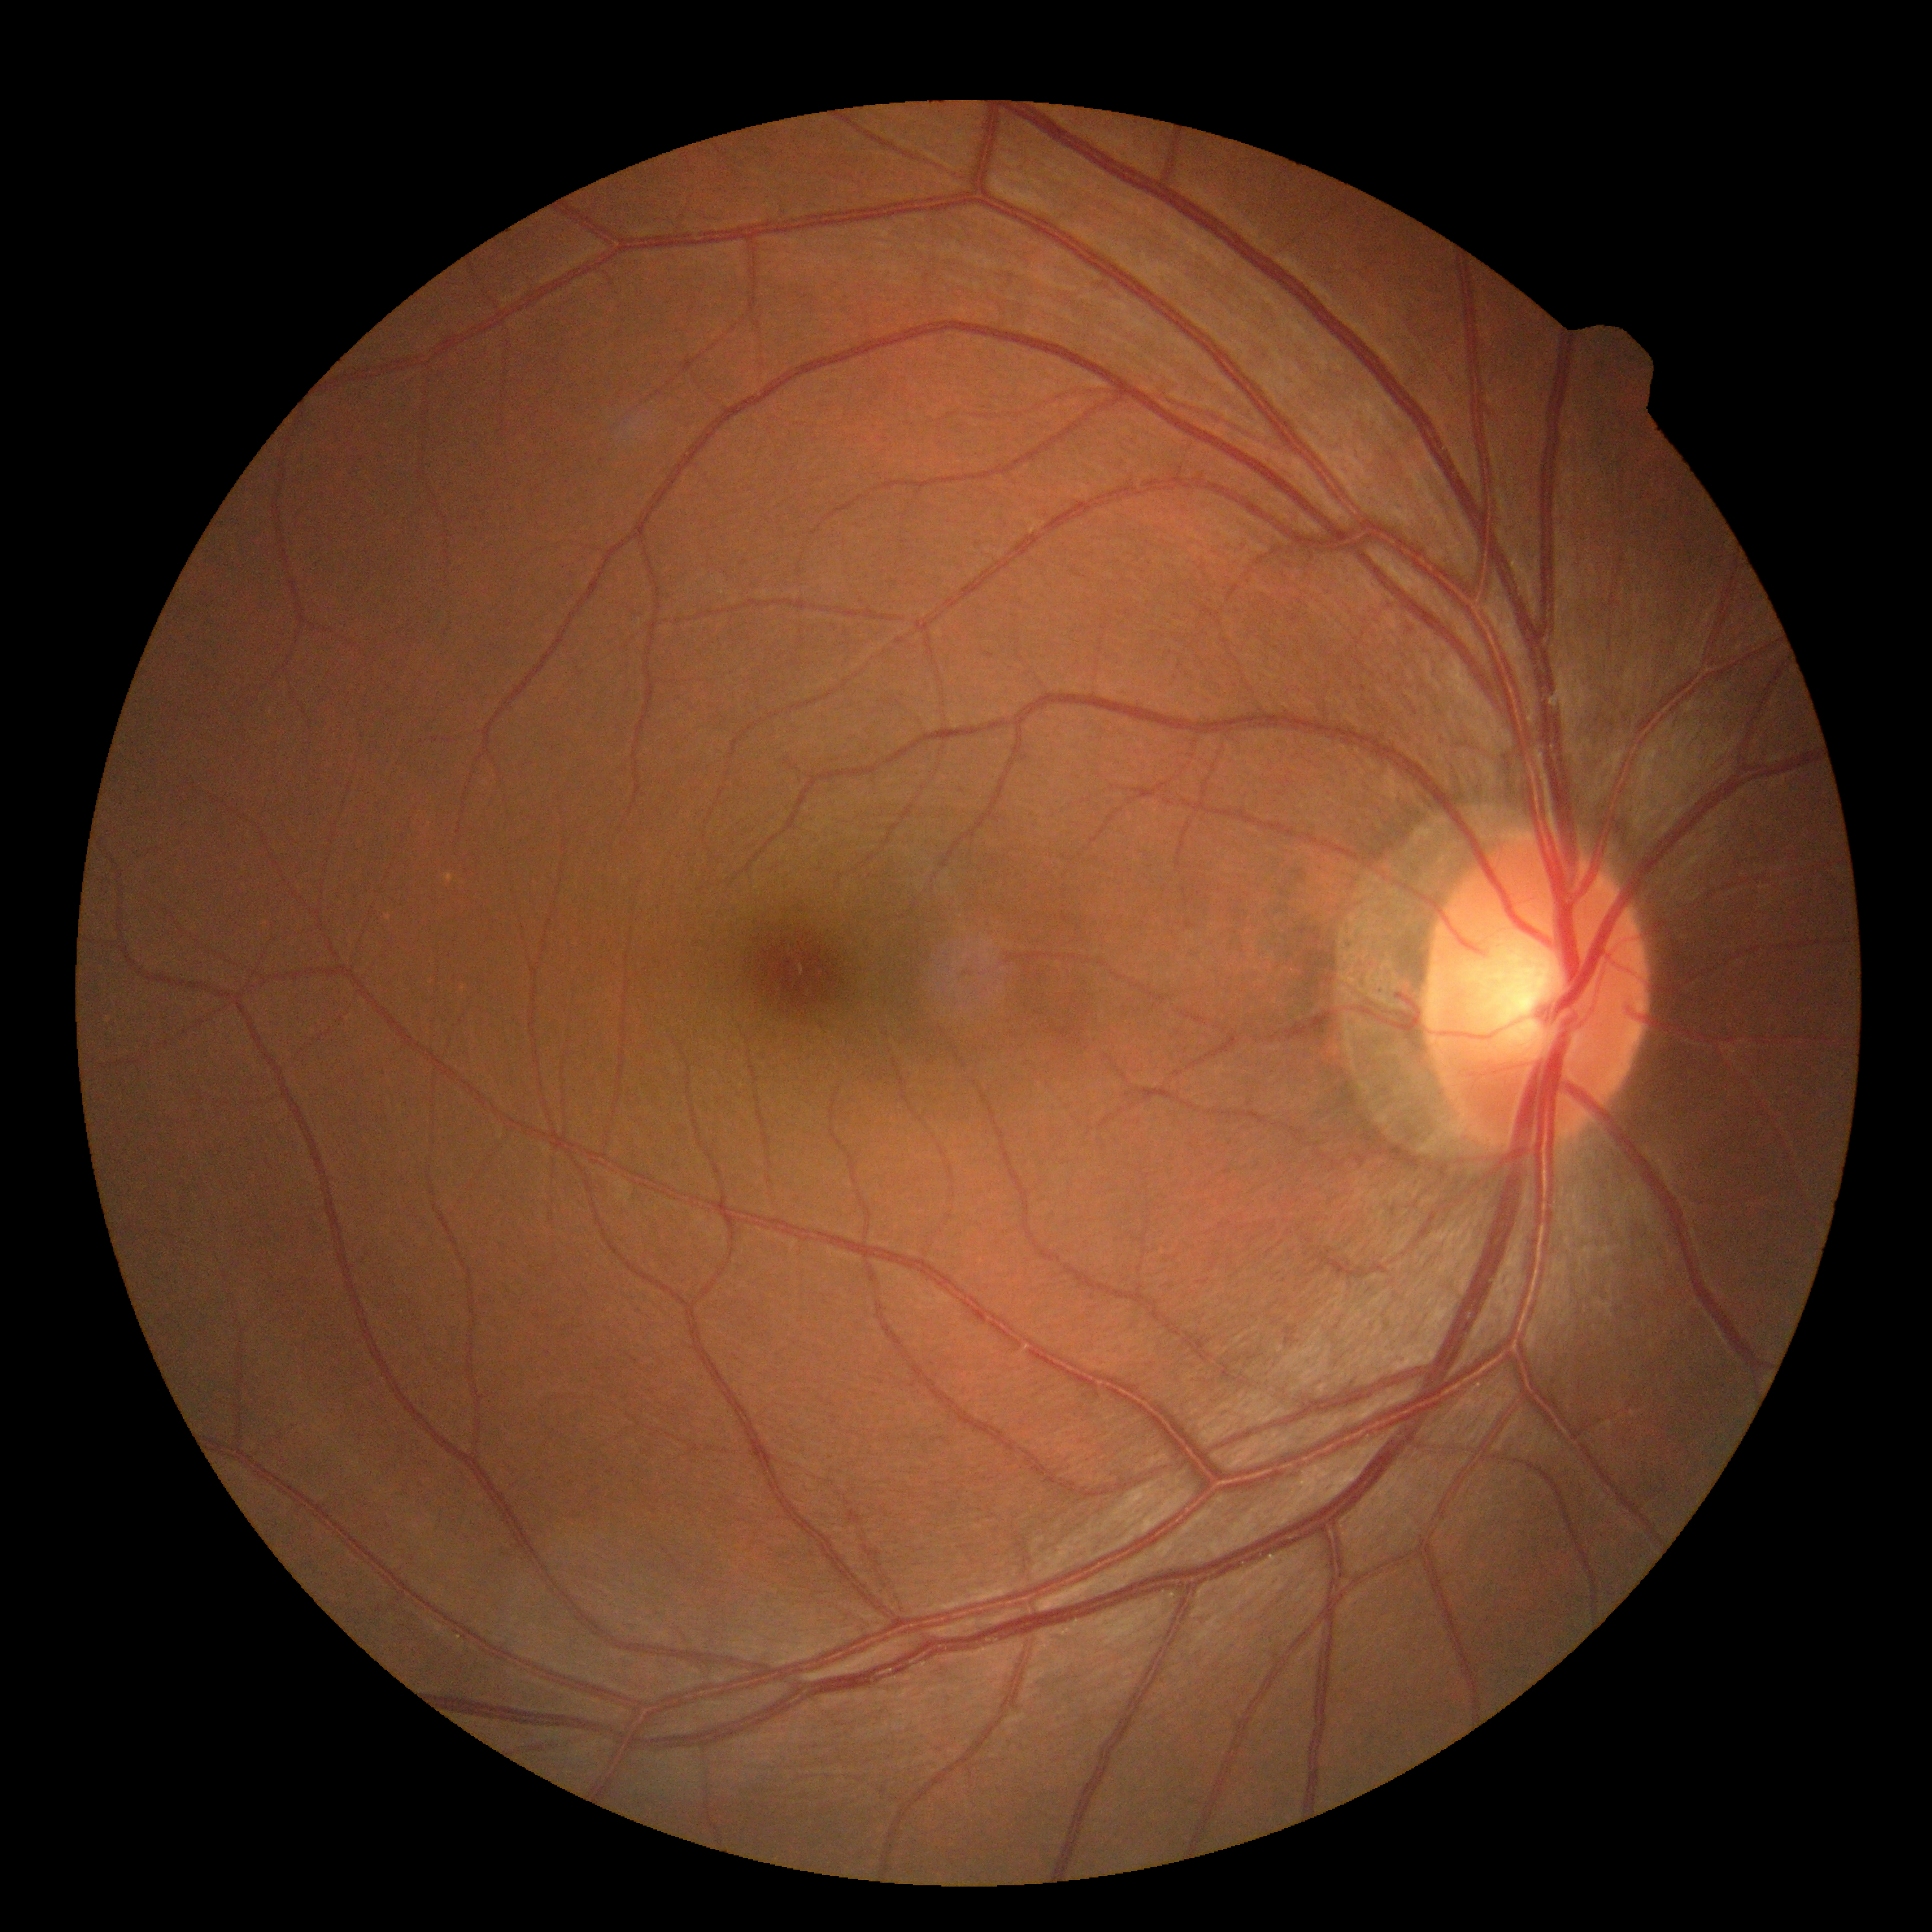 DR severity is grade 0.